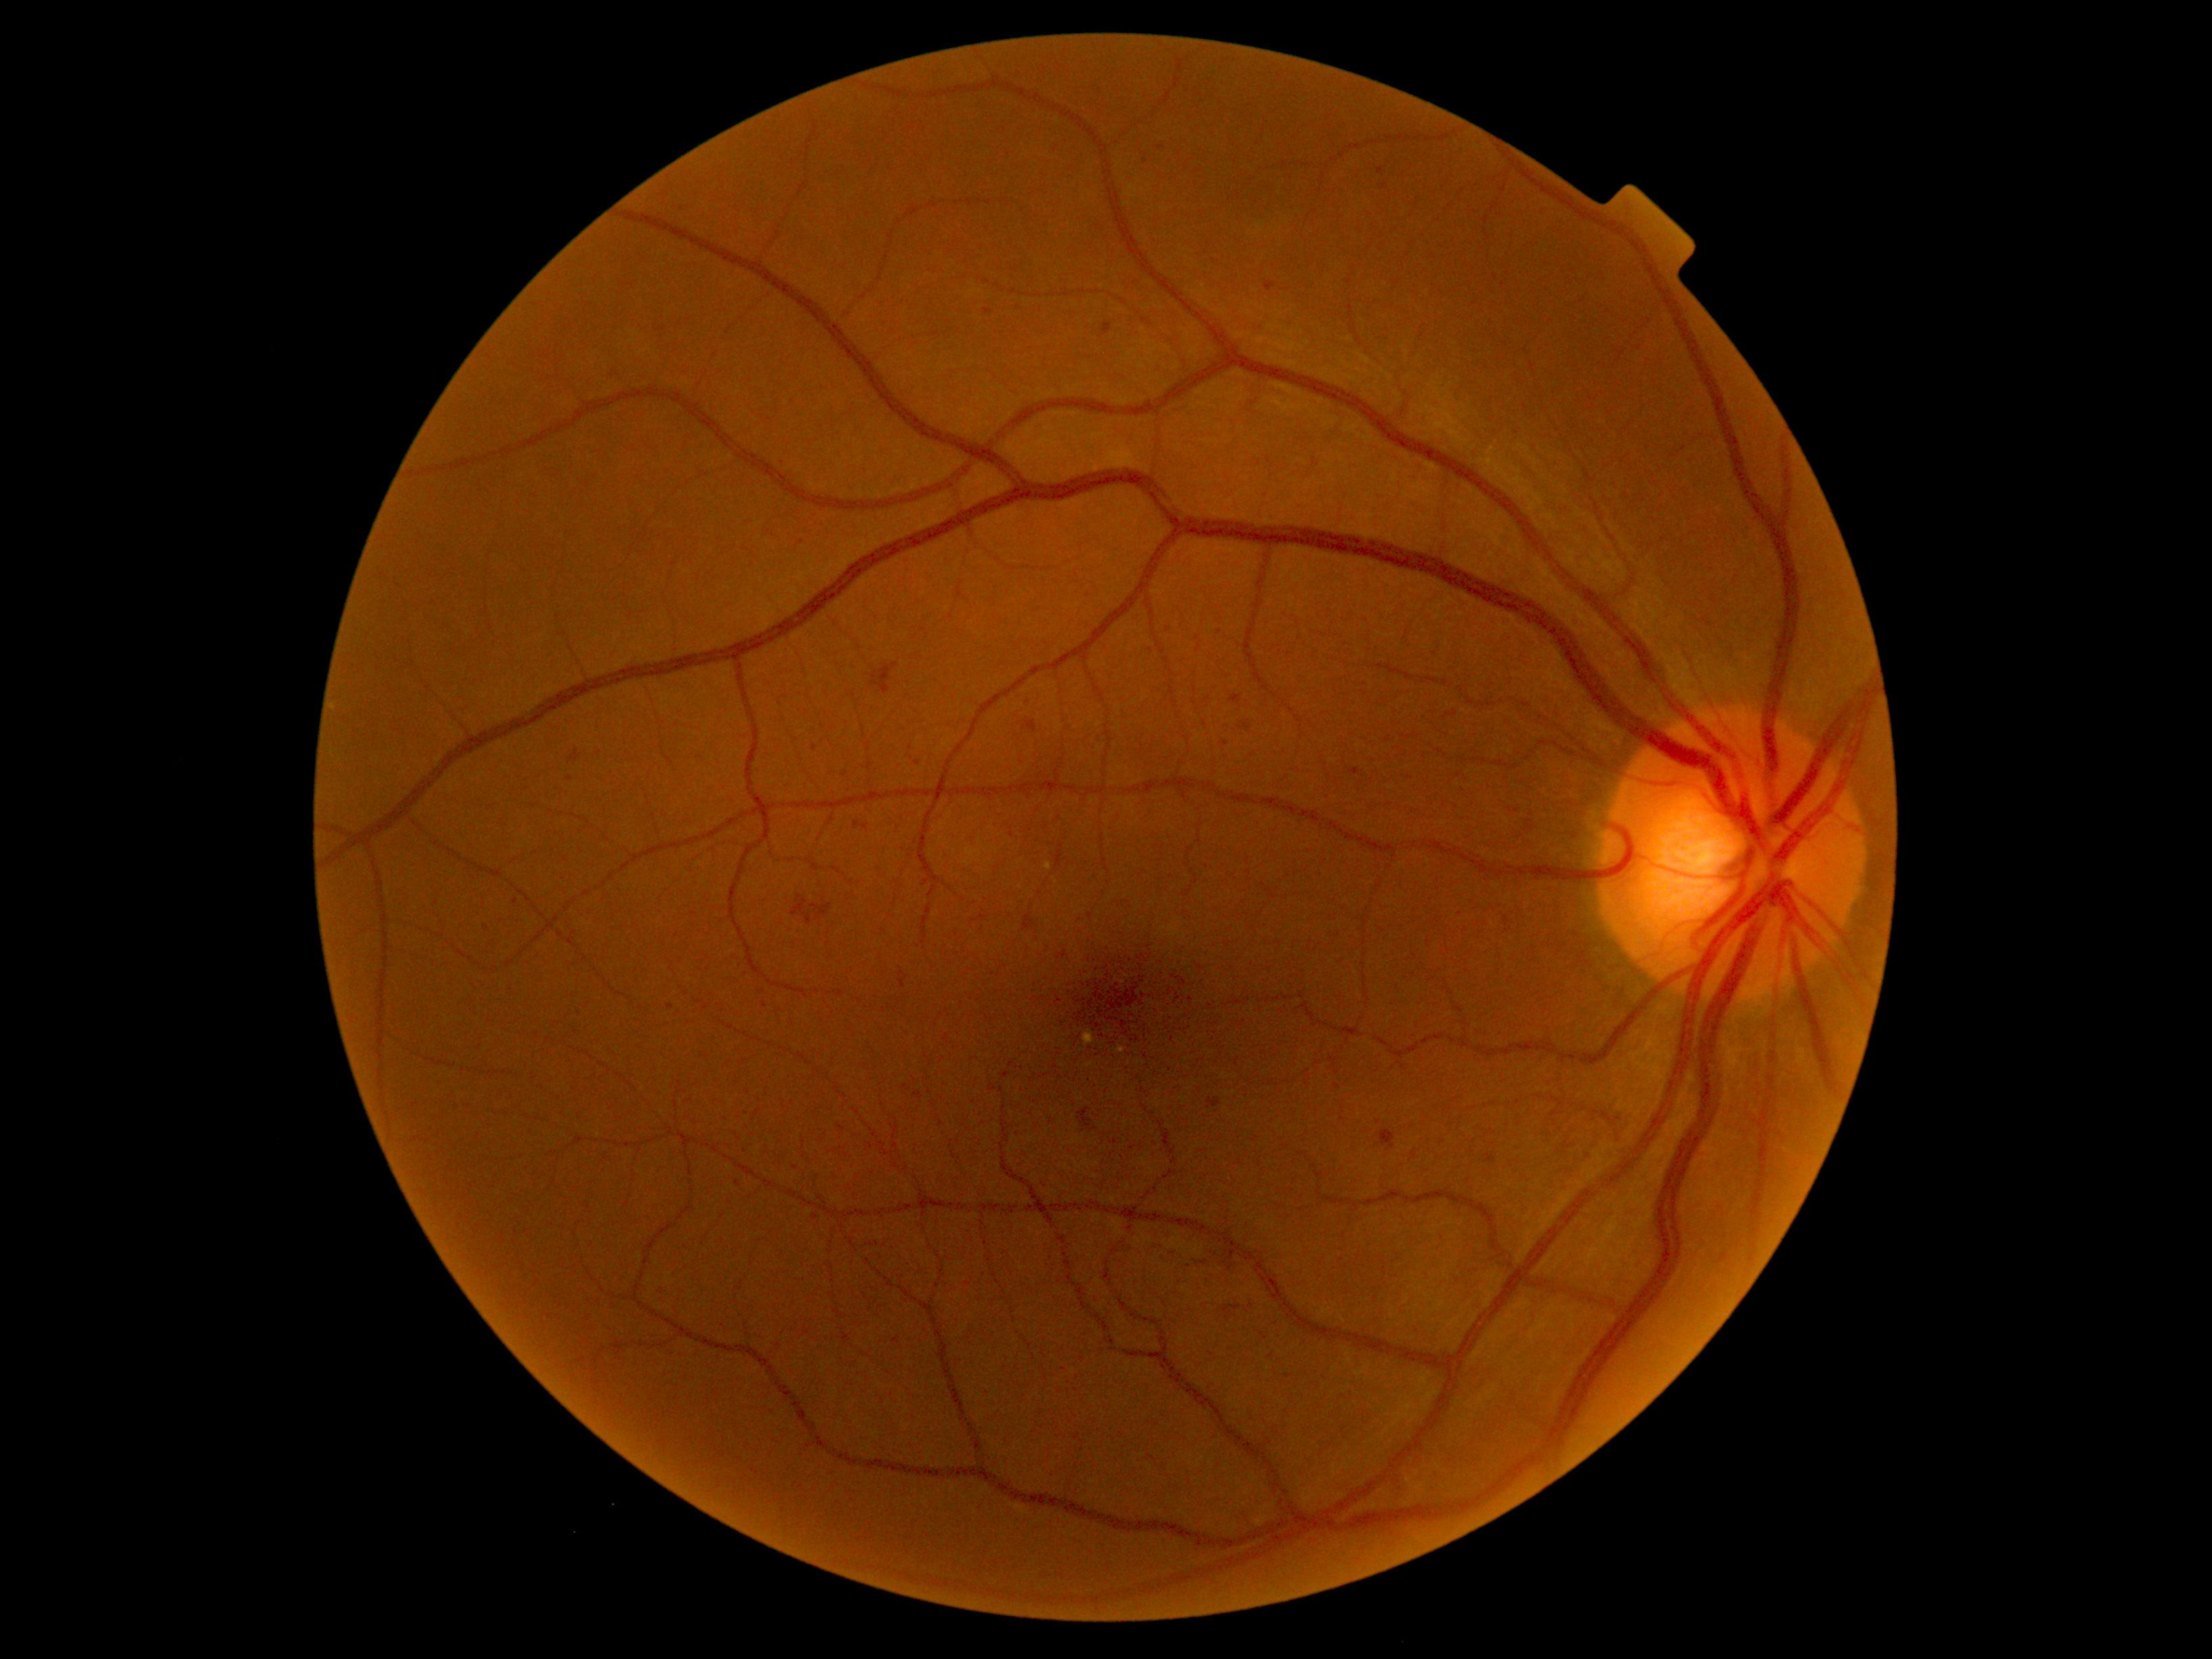
Diabetic retinopathy (DR) is moderate non-proliferative diabetic retinopathy (grade 2)
Selected lesions:
hemorrhages (HEs) (continued): box=[1013, 304, 1024, 314]; box=[1078, 1108, 1093, 1127]; box=[1486, 1154, 1496, 1164]; box=[575, 1010, 585, 1017]; box=[871, 1241, 879, 1246]; box=[855, 821, 868, 830]; box=[792, 895, 813, 925]; box=[1223, 1306, 1241, 1319]; box=[742, 1147, 749, 1155]; box=[1023, 914, 1033, 930]; box=[901, 981, 905, 989]
Additional small HEs near pt(1364, 782); pt(1567, 1145); pt(918, 763); pt(815, 1217); pt(737, 1183); pt(759, 1166); pt(739, 1138); pt(988, 311); pt(823, 901)